NIDEK AFC-230 fundus camera: 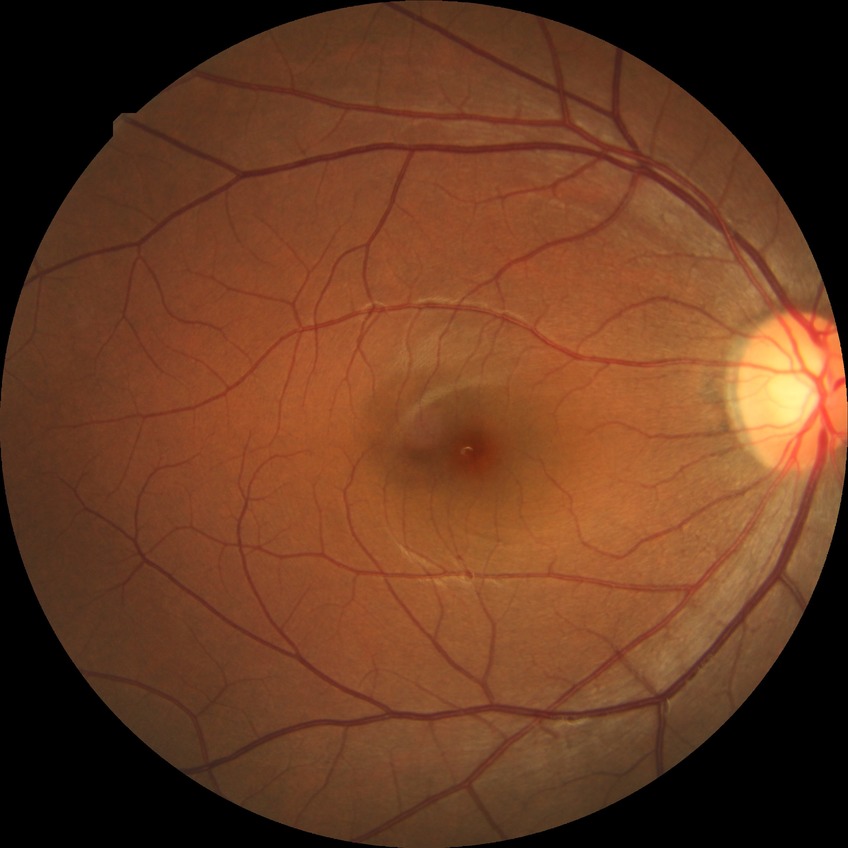
– retinopathy grade: no diabetic retinopathy